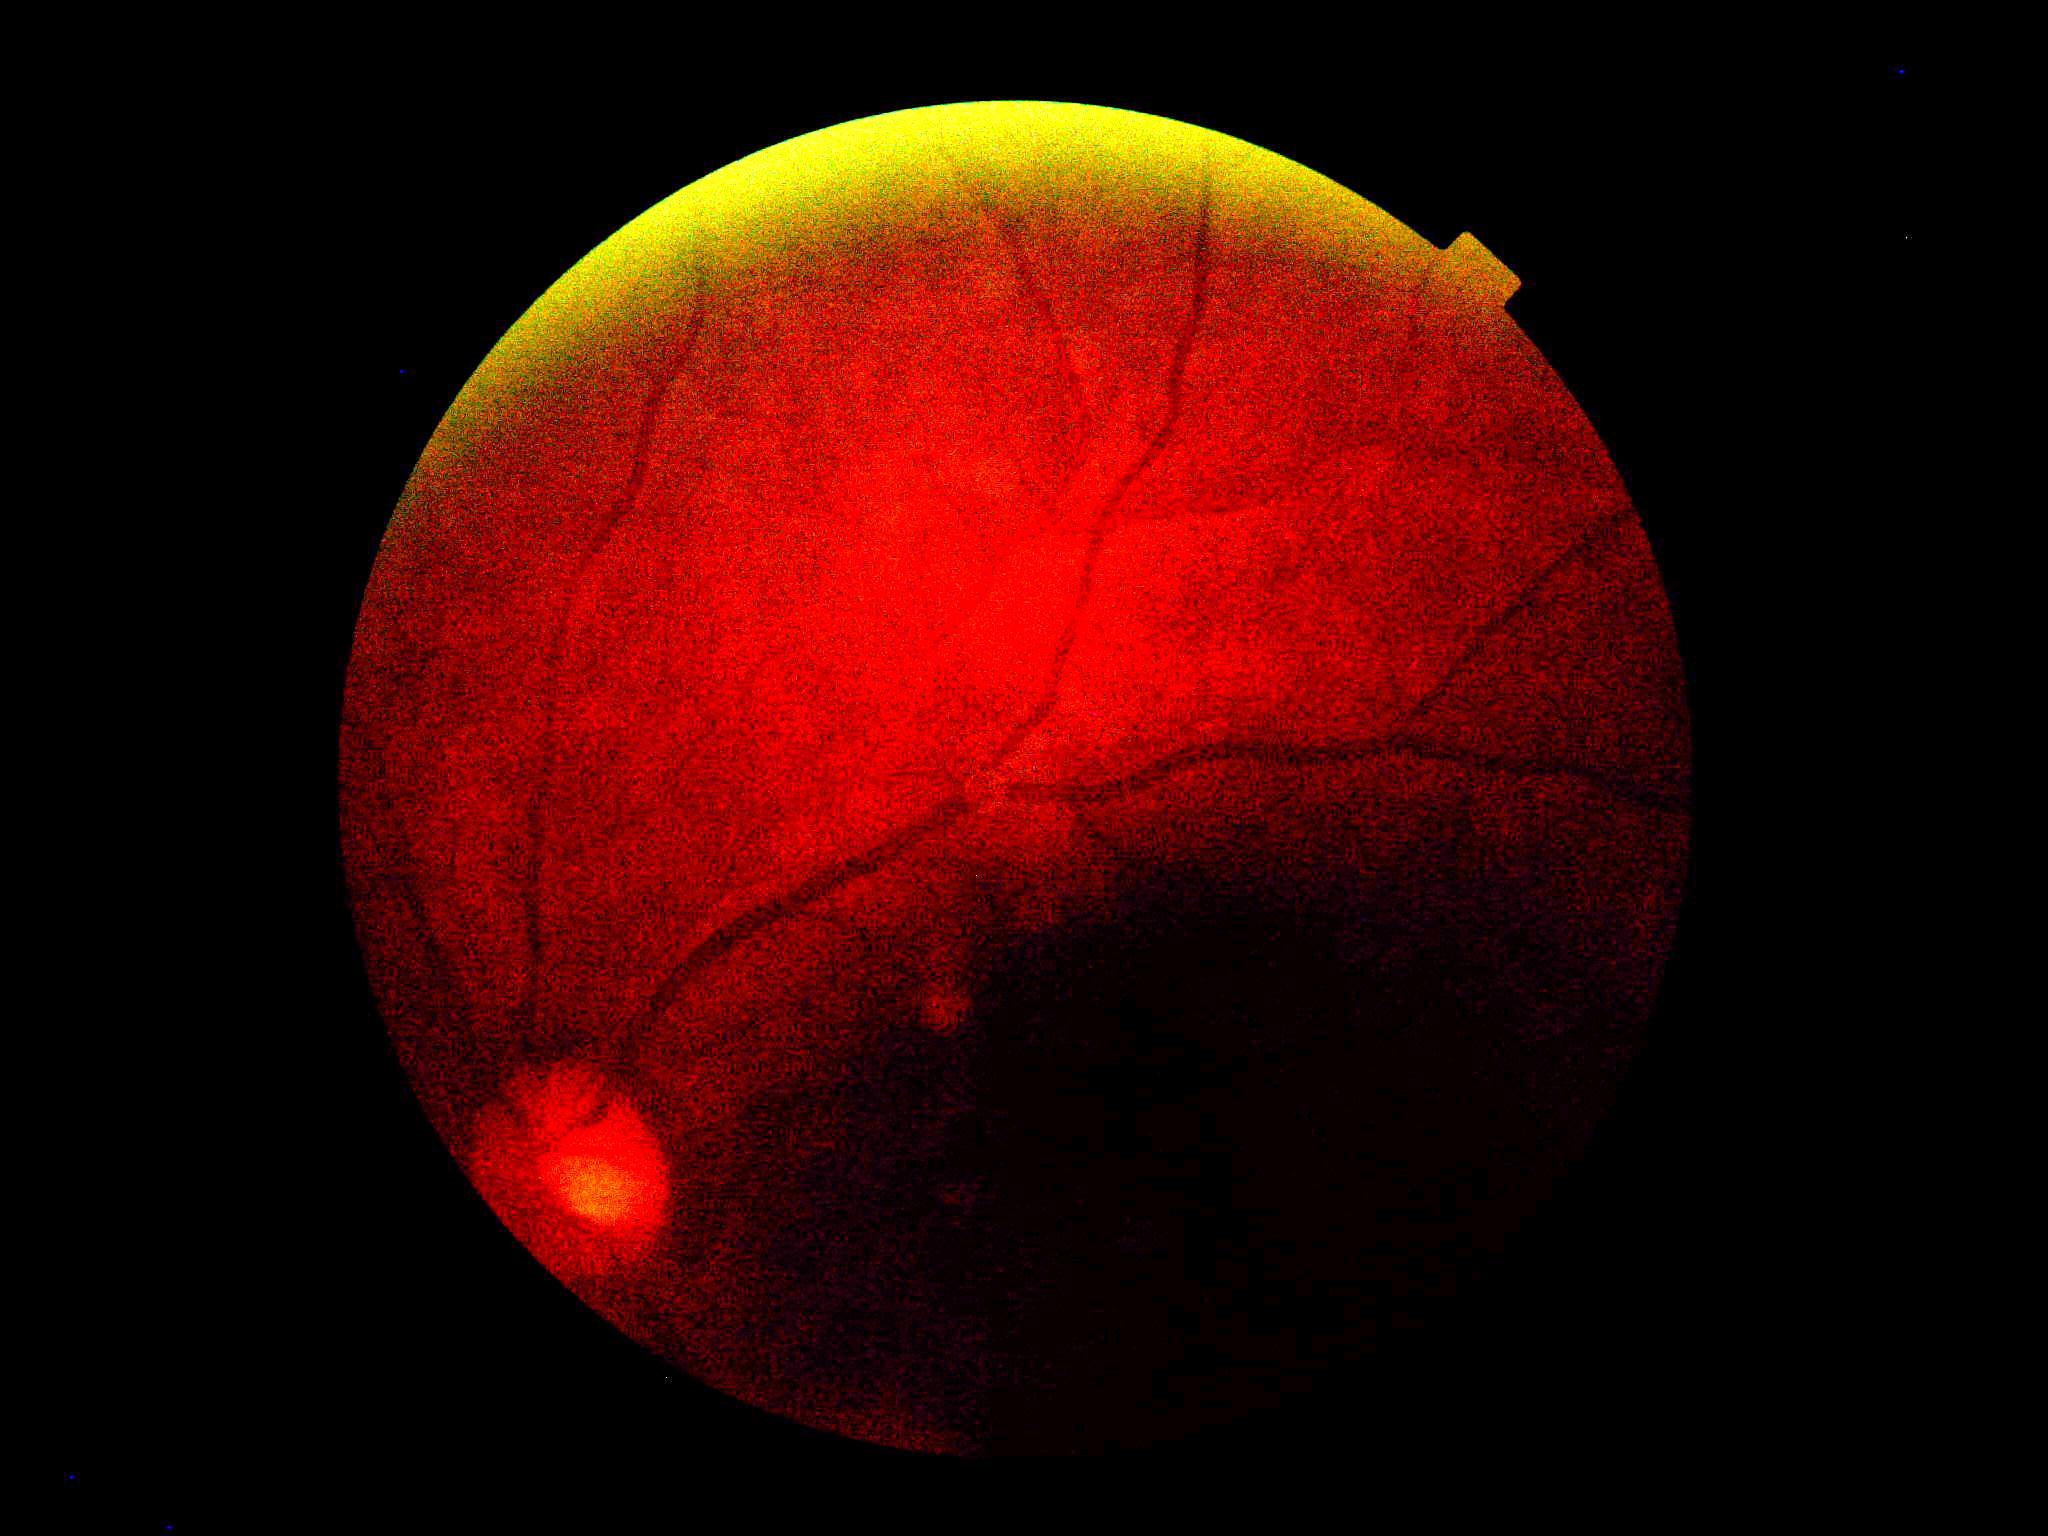
DR severity: ungradable due to poor image quality.
Ungradable image — DR severity cannot be determined.